CFP, modified Davis grading, 45° FOV, camera: NIDEK AFC-230, image size 848x848: 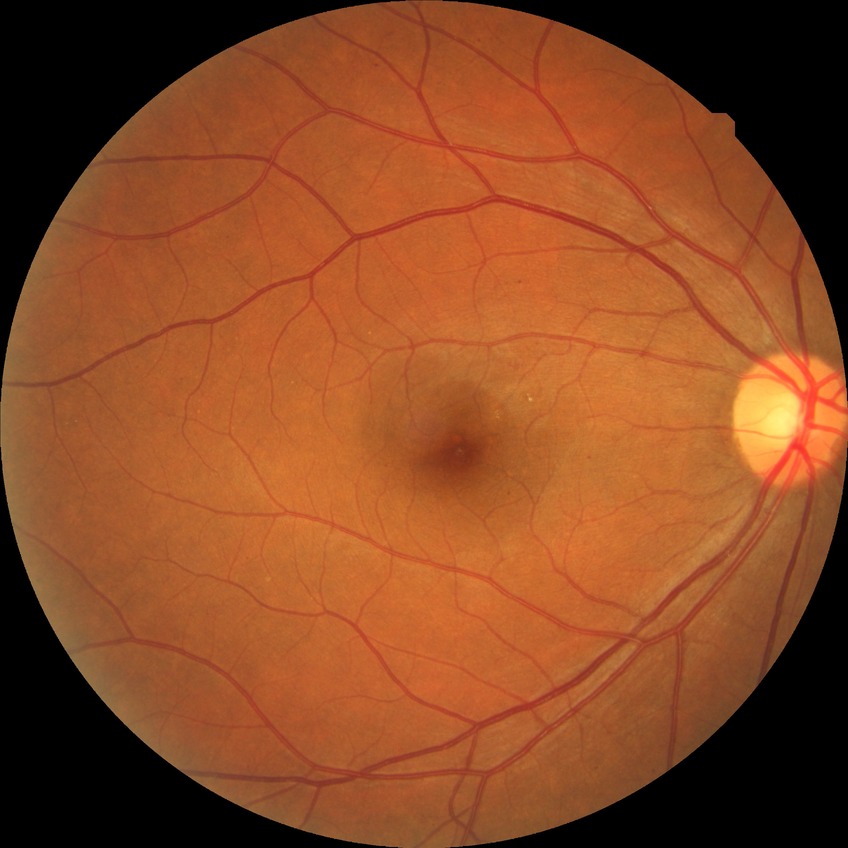

Diabetic retinopathy (DR): SDR (simple diabetic retinopathy).